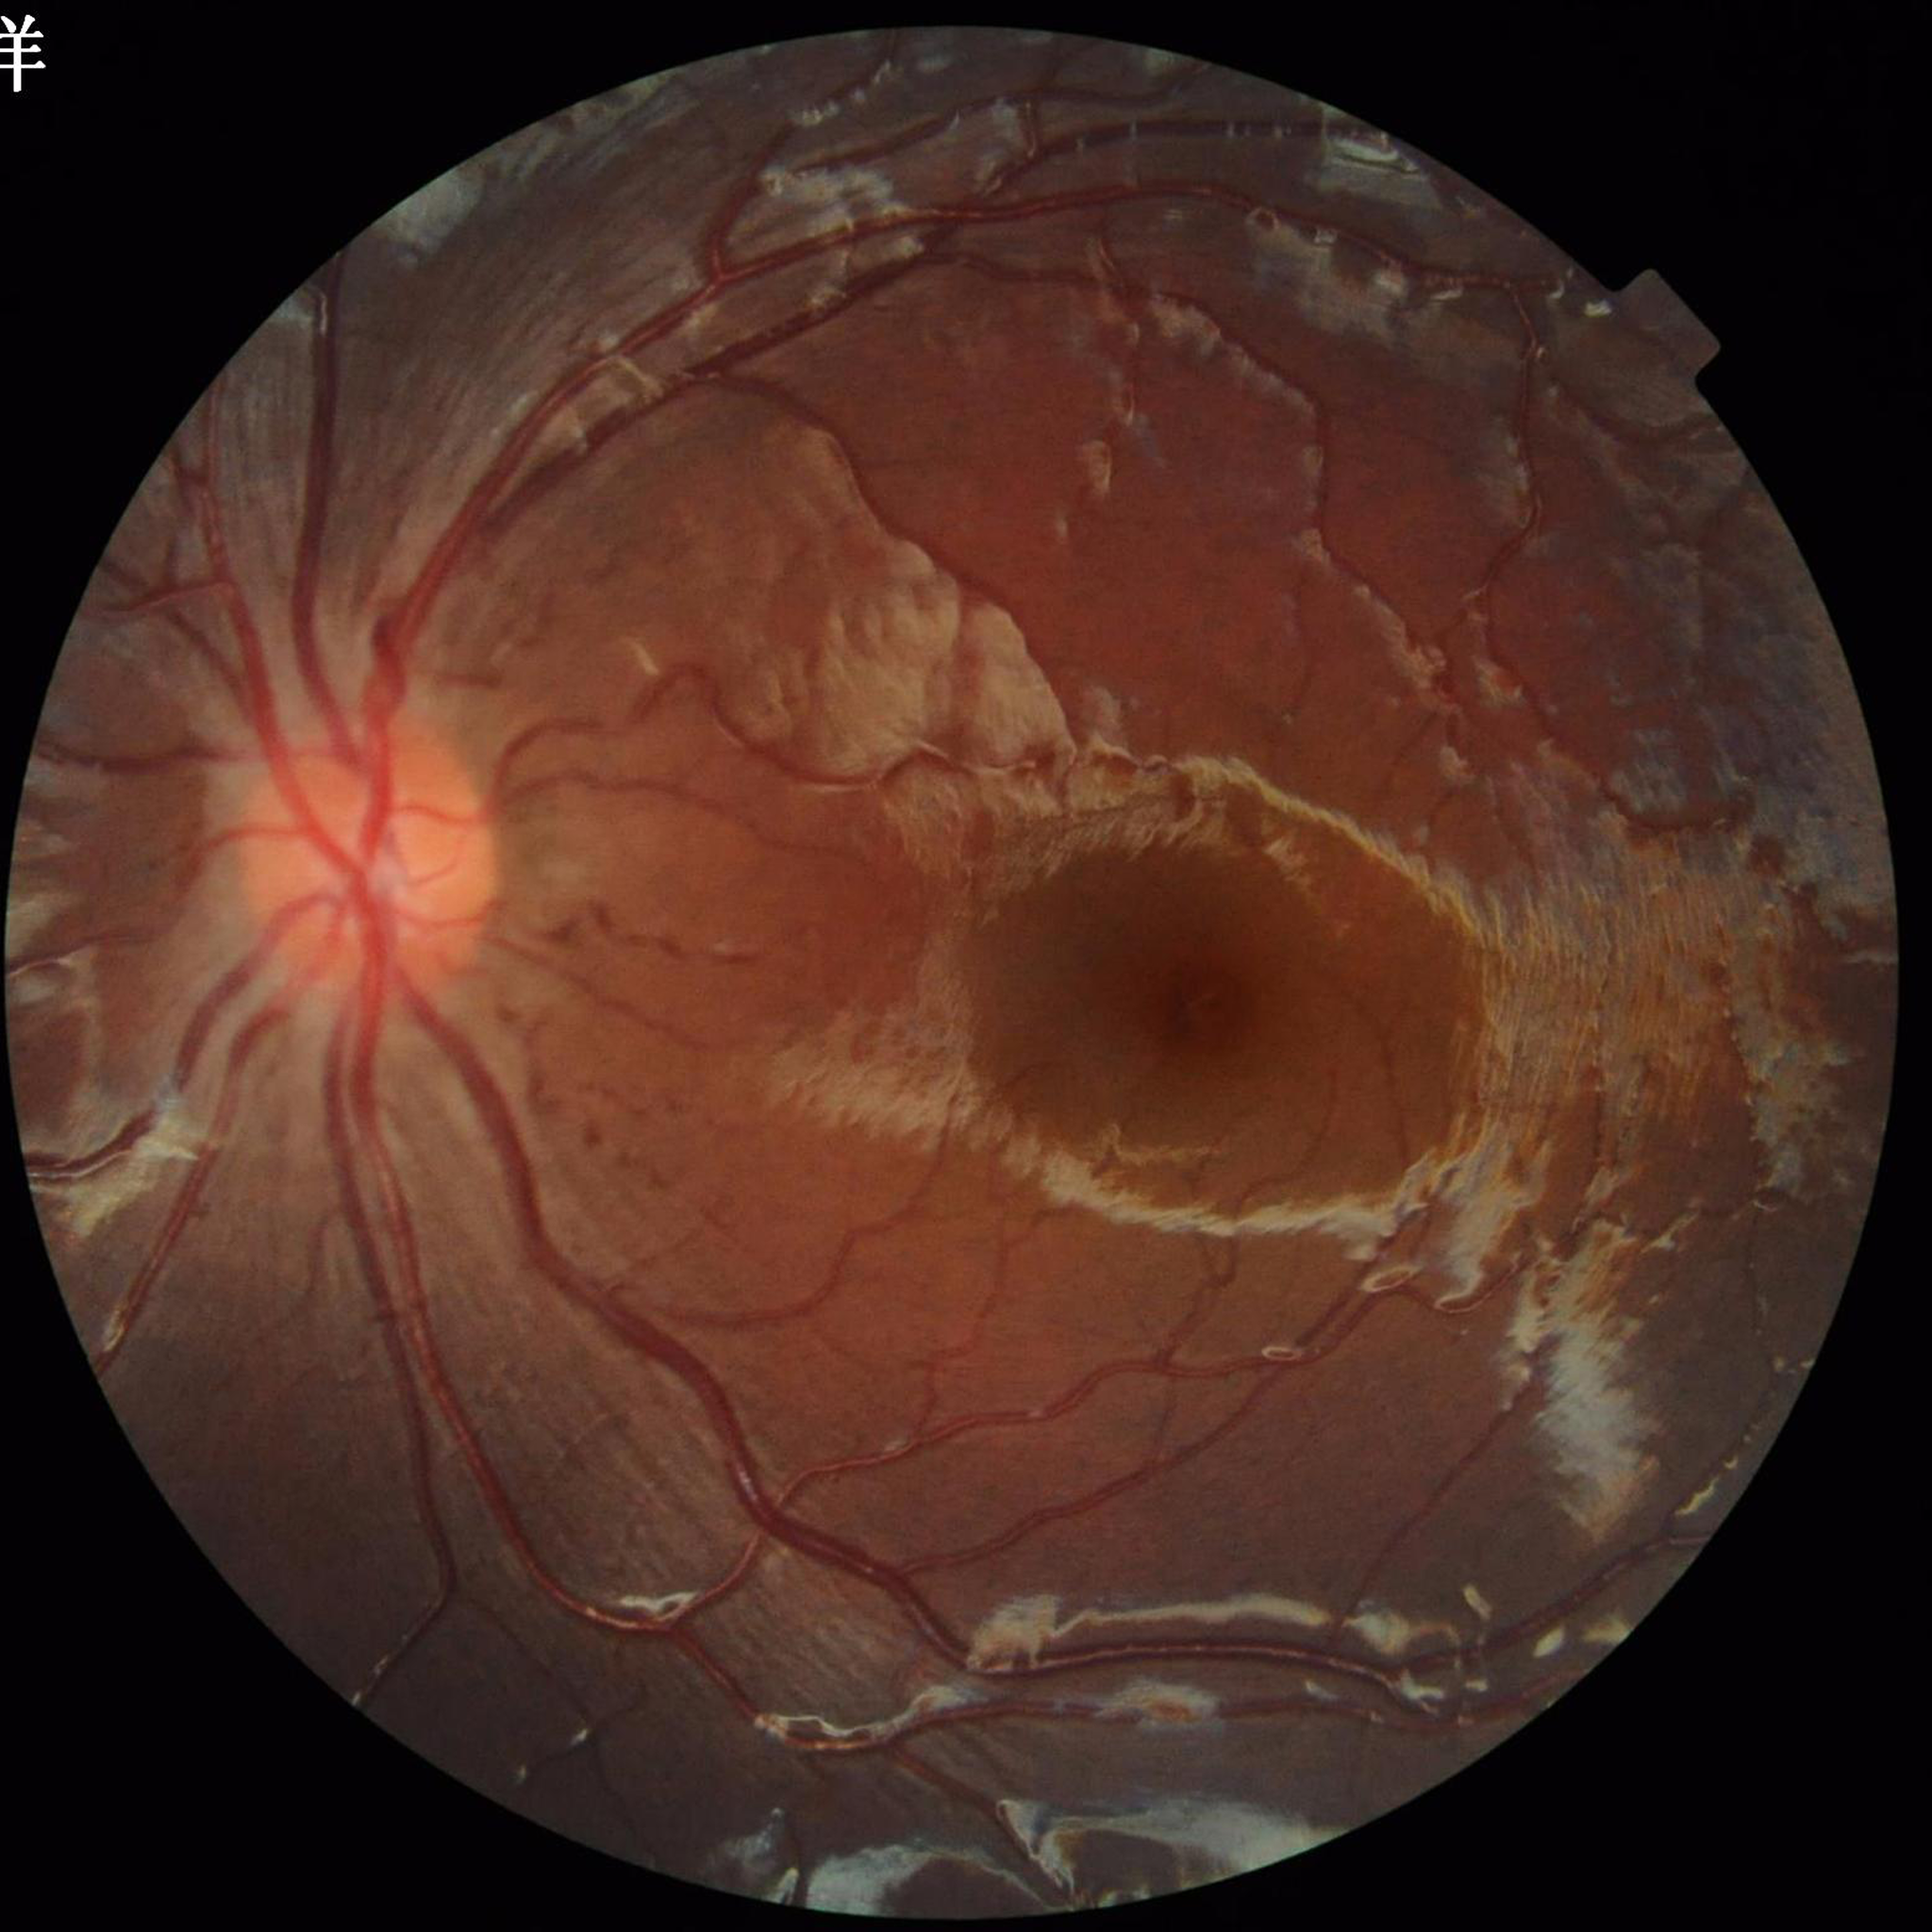 Impression = no AMD, DR, or glaucomatous findings